45-degree field of view:
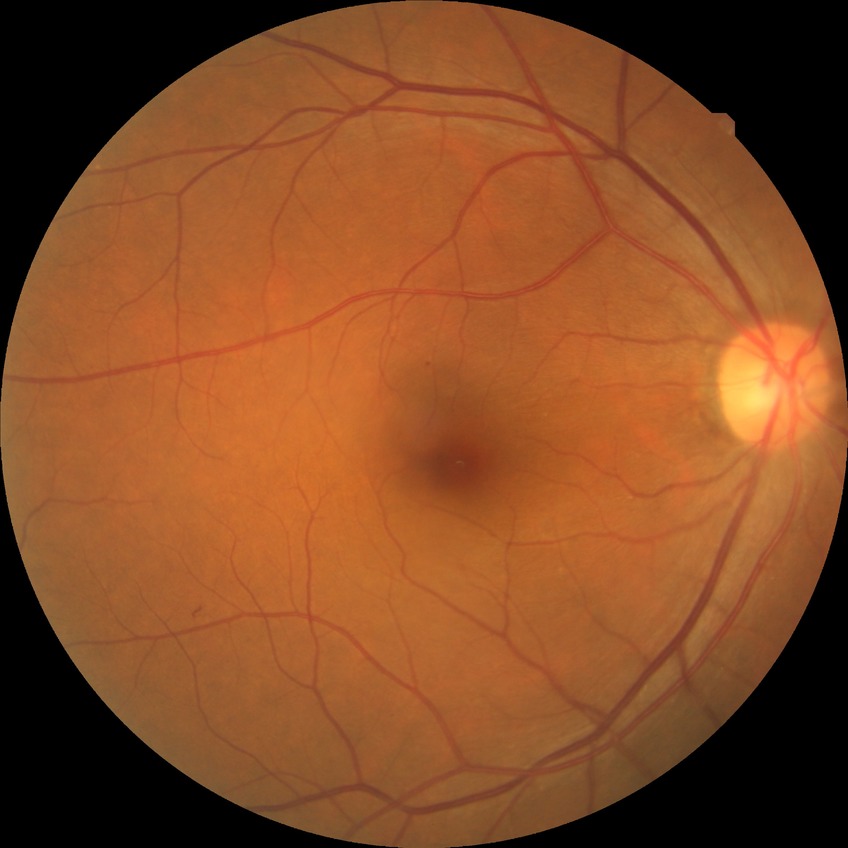
* DR class — non-proliferative diabetic retinopathy
* diabetic retinopathy stage — simple diabetic retinopathy